1932x1916, fundus photo
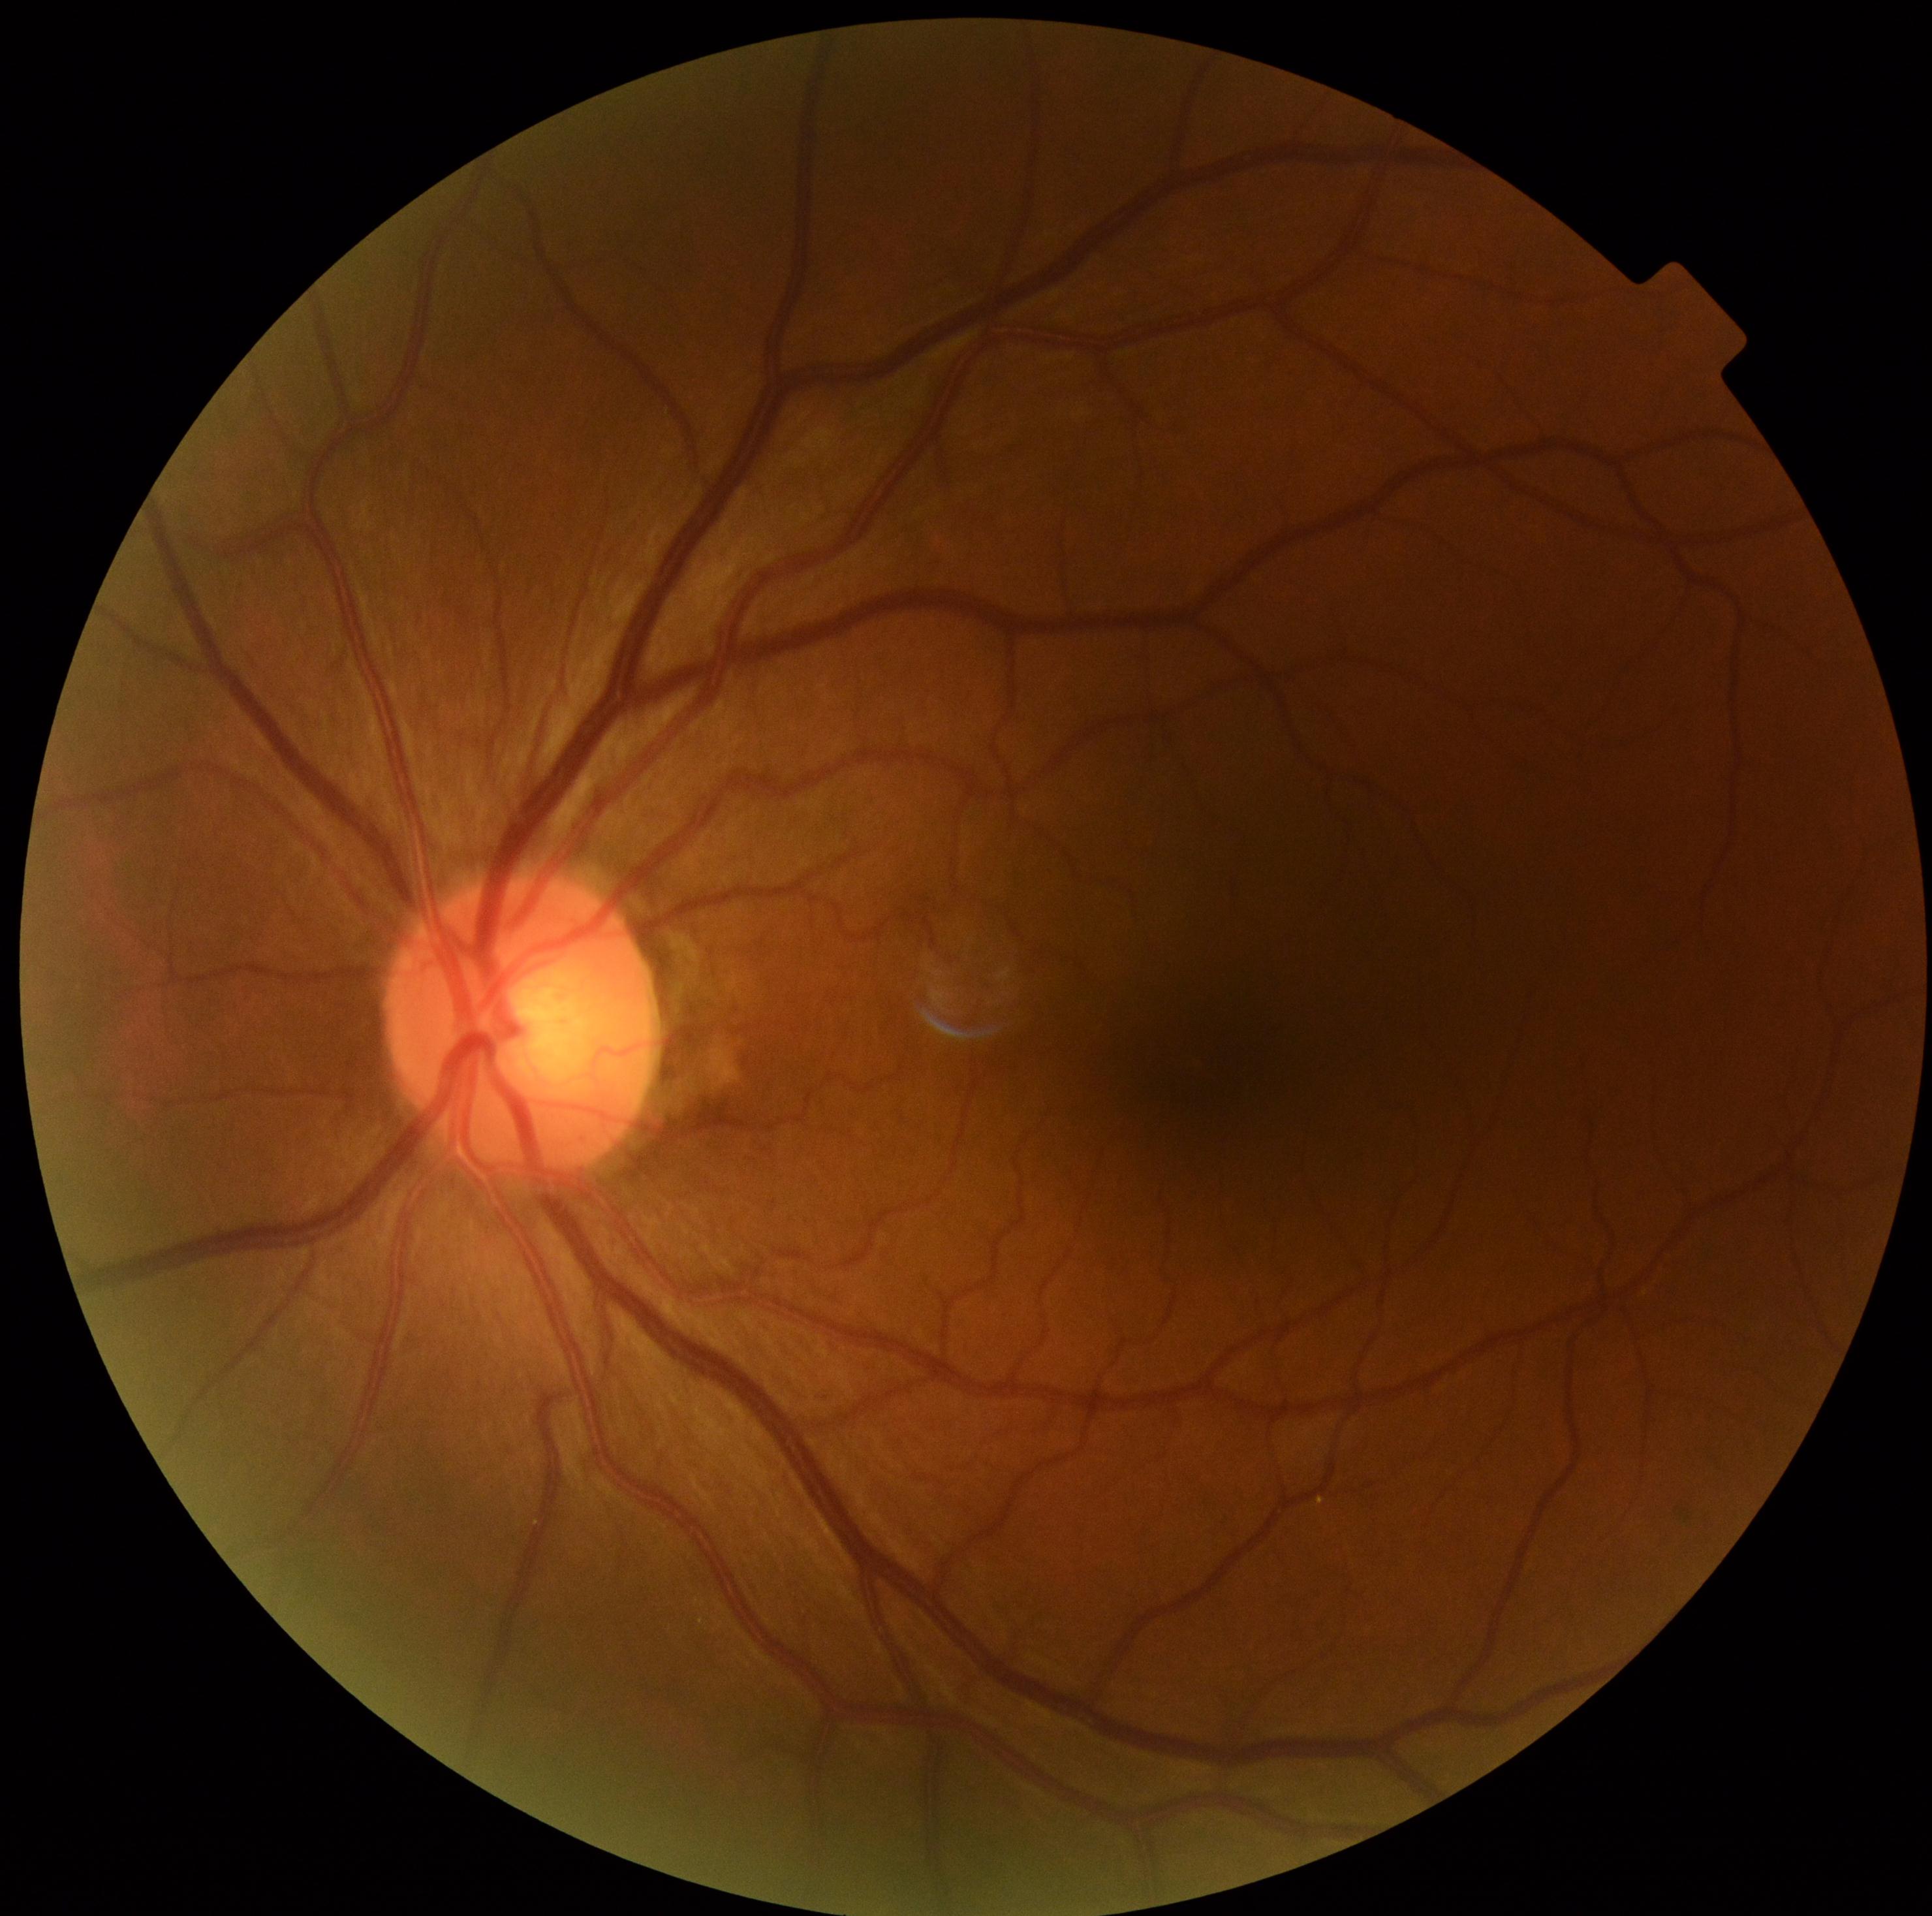 No apparent diabetic retinopathy. DR grade: 0 (no apparent retinopathy).